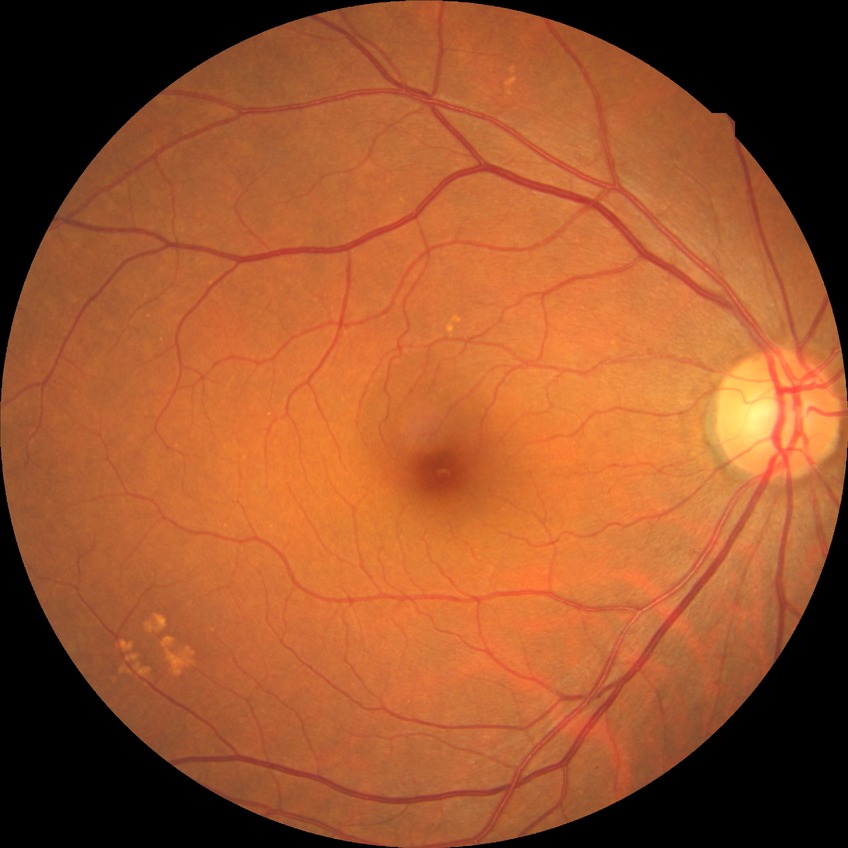
Retinopathy stage is no diabetic retinopathy.